Wide-field fundus photograph from neonatal ROP screening · 1240 by 1240 pixels.
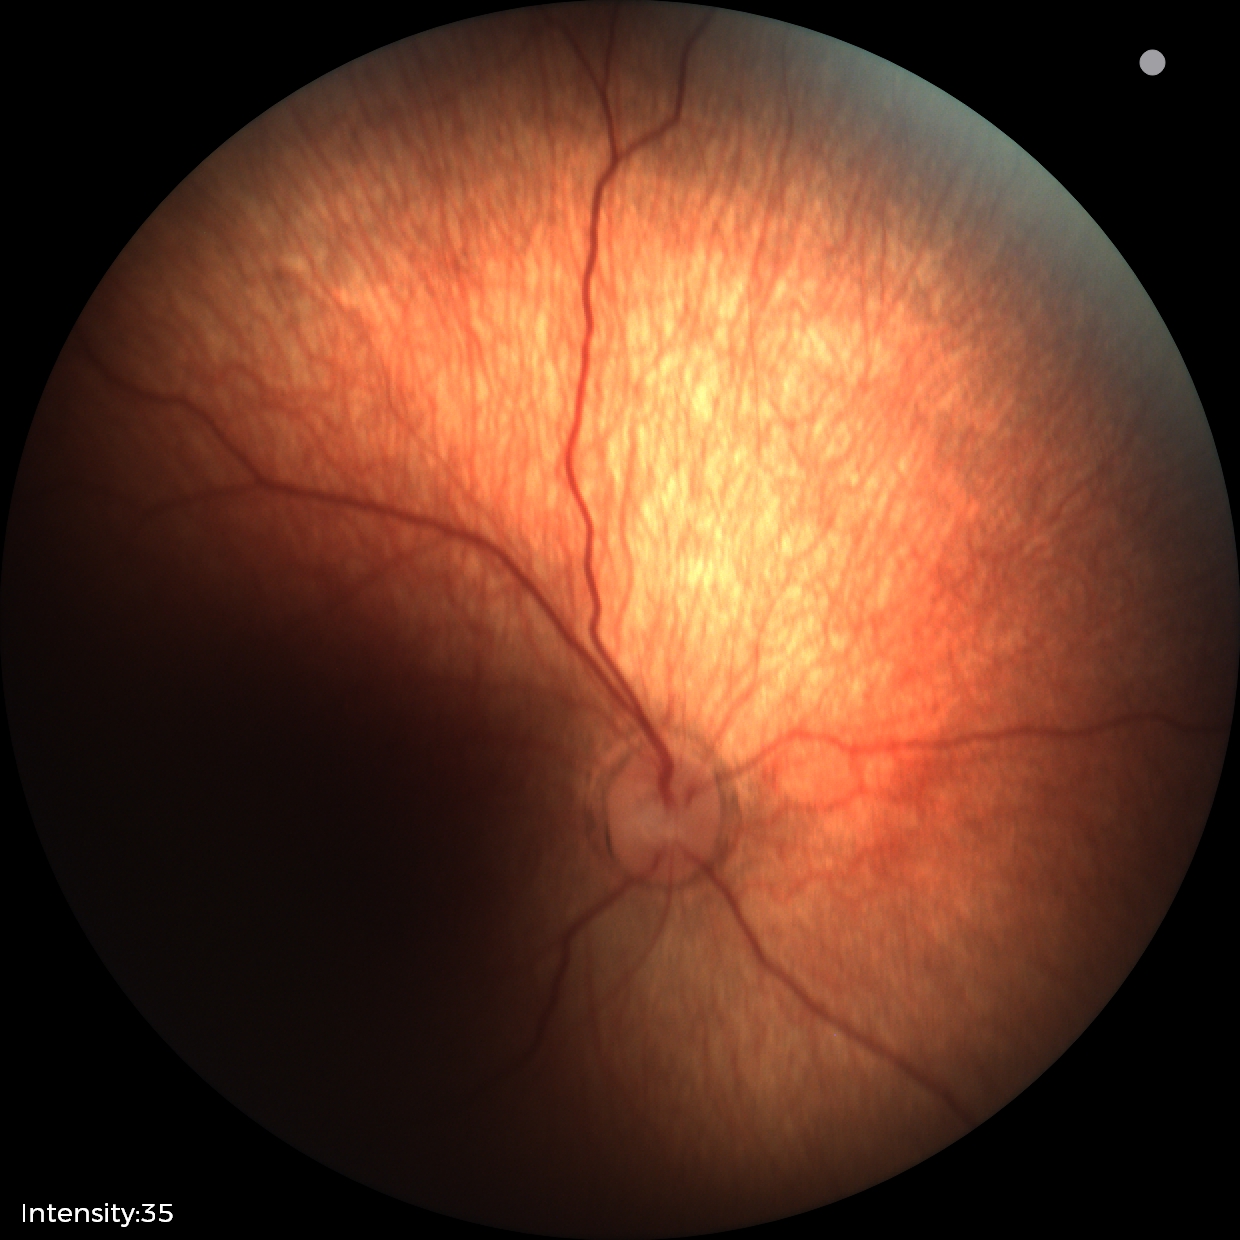

Screening diagnosis: normal retinal appearance.